Modified Davis classification:
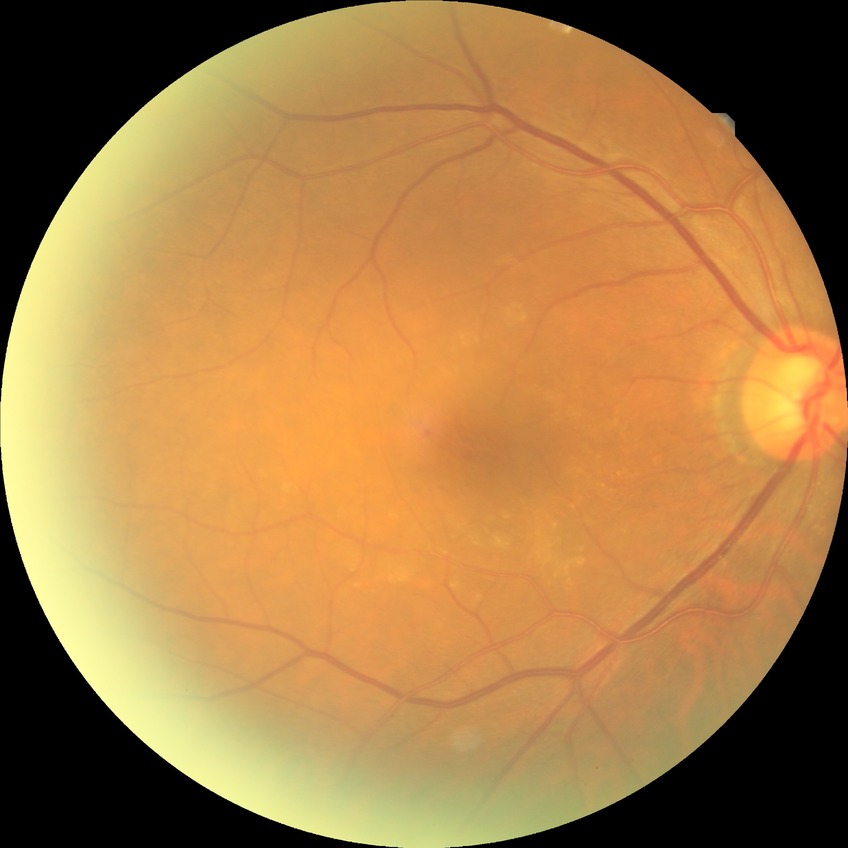 DR class: non-proliferative diabetic retinopathy; diabetic retinopathy (DR): SDR (simple diabetic retinopathy).